1932 by 1932 pixels. CFP:
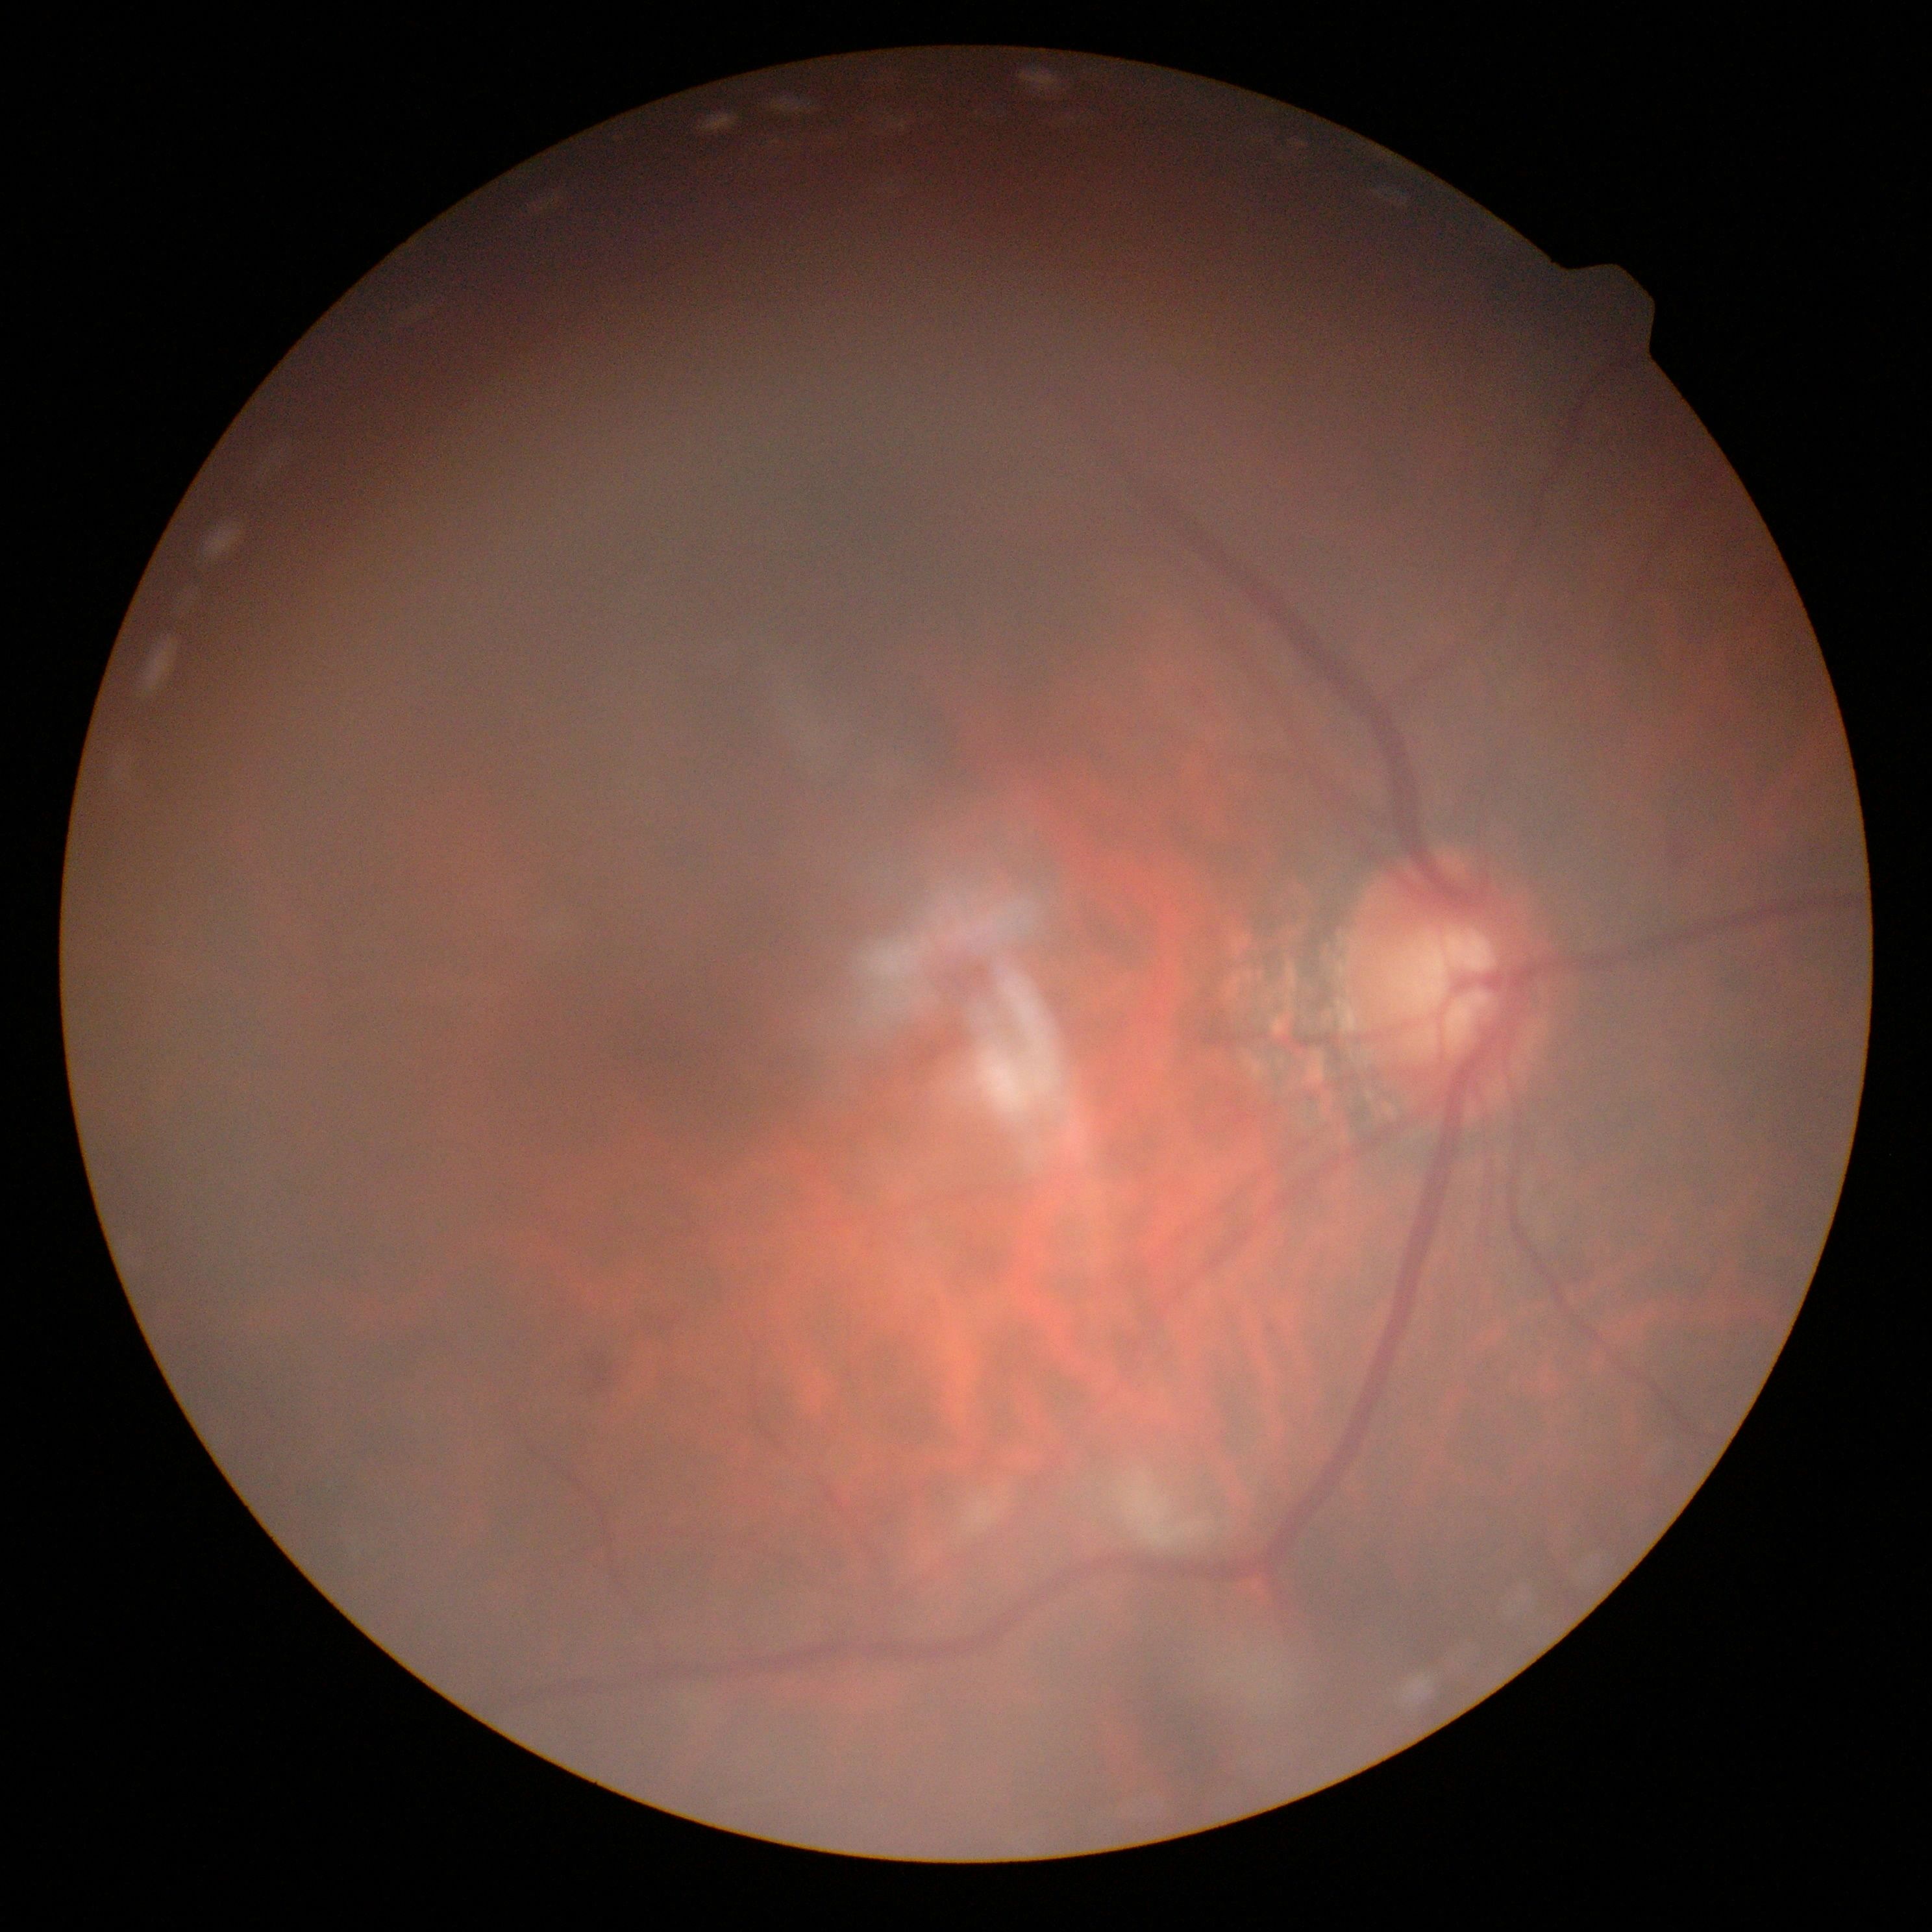
- DR stage: 2